Modified Davis grading — 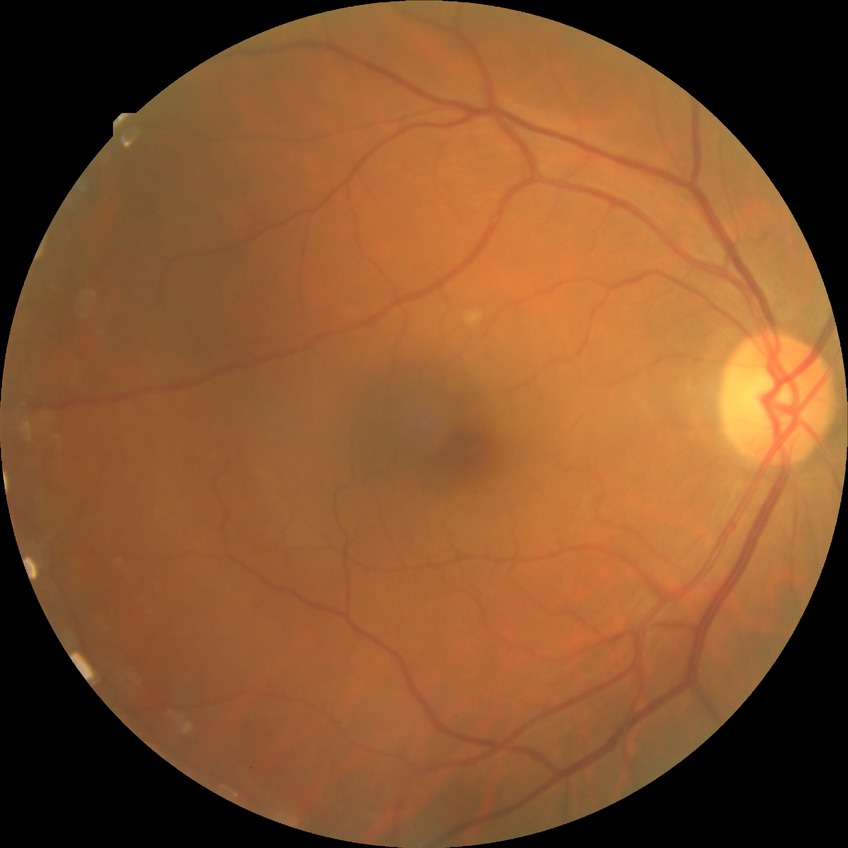

DR is NDR. No signs of diabetic retinopathy.